Handheld portable fundus camera image.
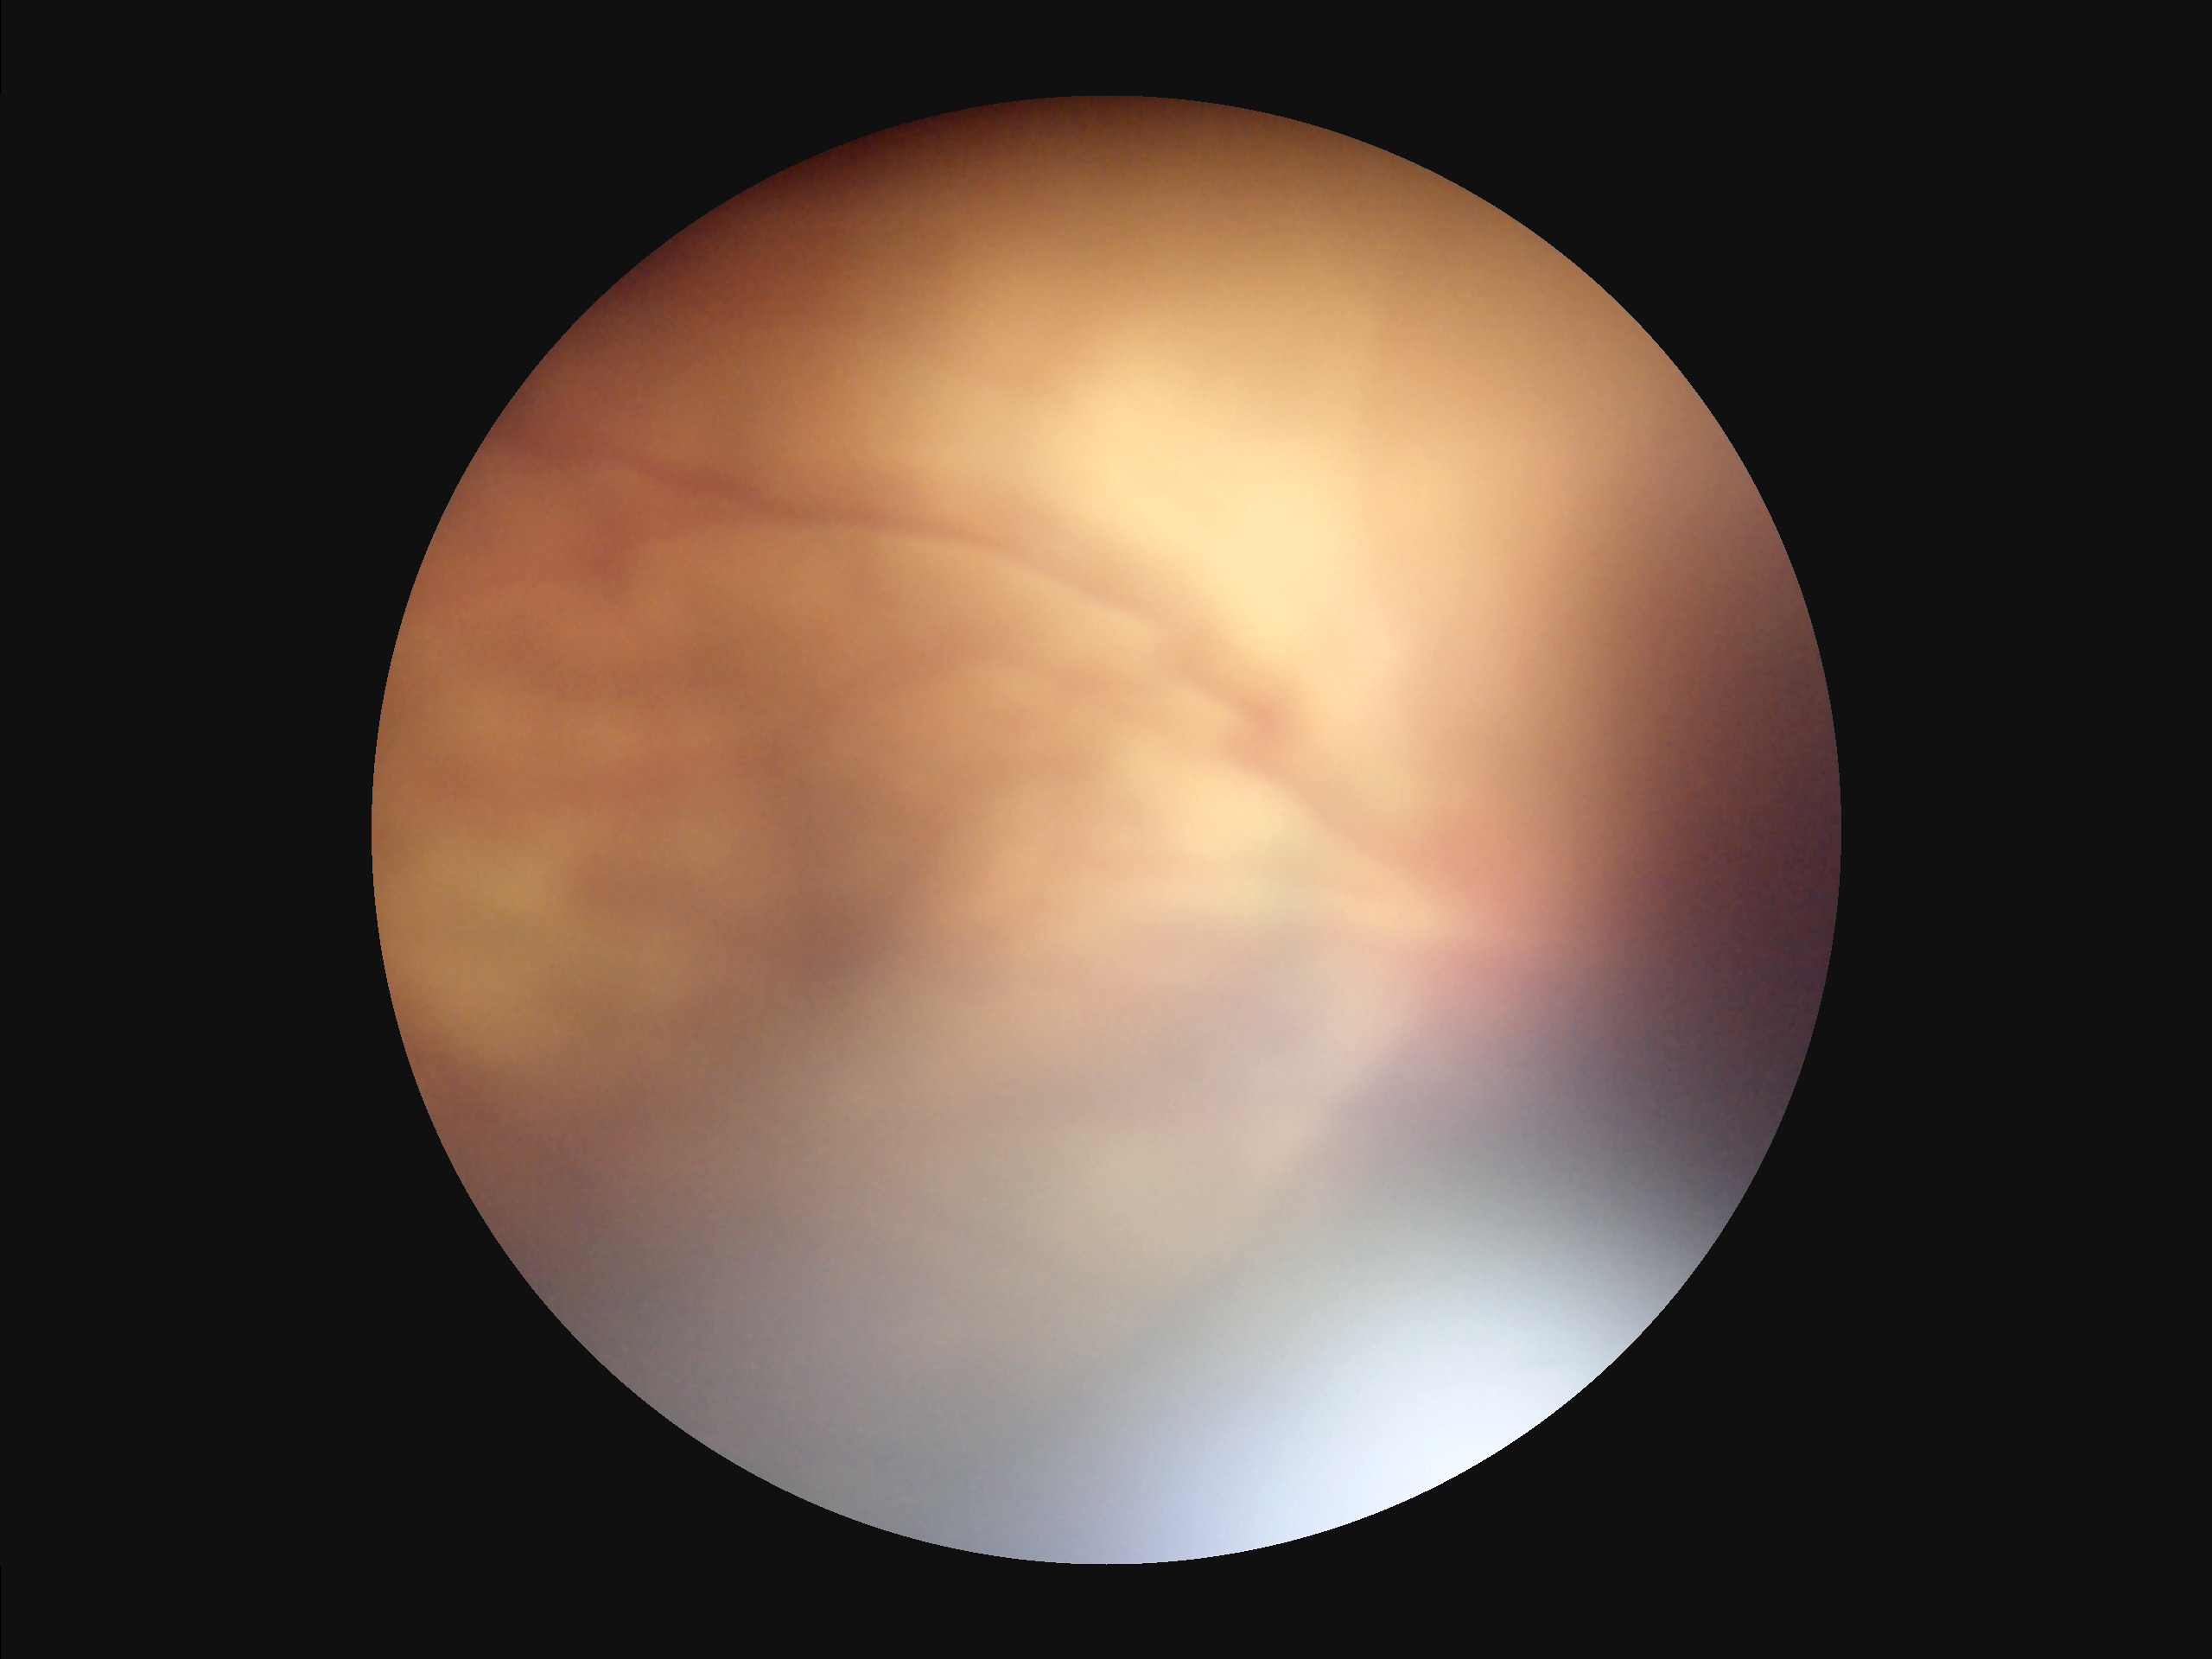
{
  "overall_quality": "suboptimal",
  "contrast": "poor",
  "clarity": "reduced",
  "illumination": "poor"
}